848x848px:
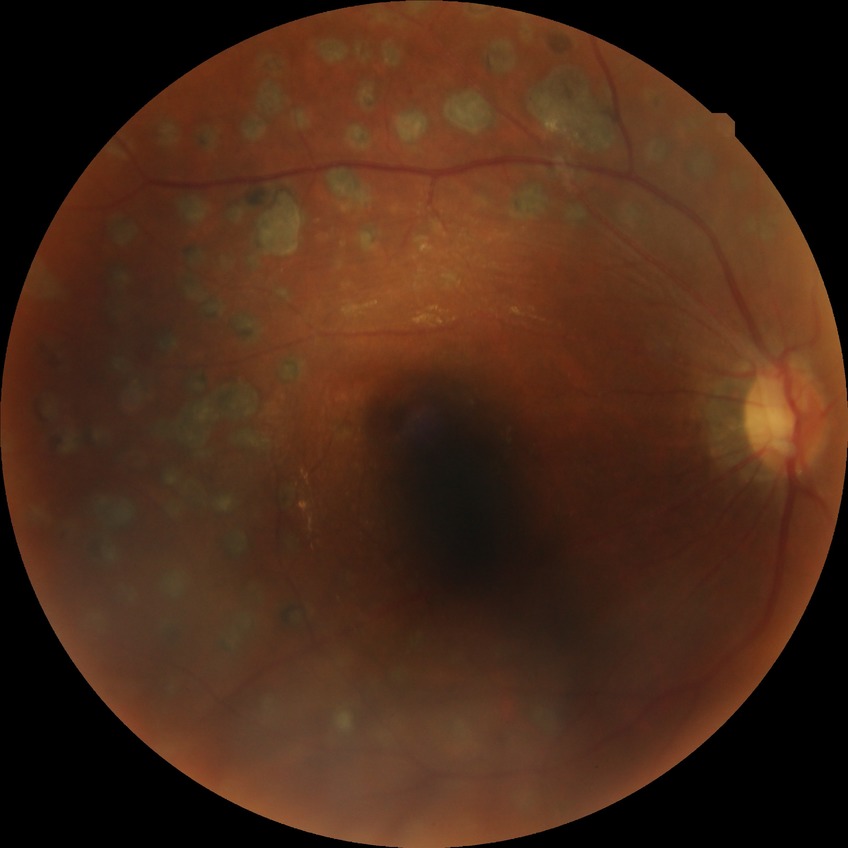 diabetic retinopathy severity@proliferative diabetic retinopathy.